Wide-field retinal mosaic image: 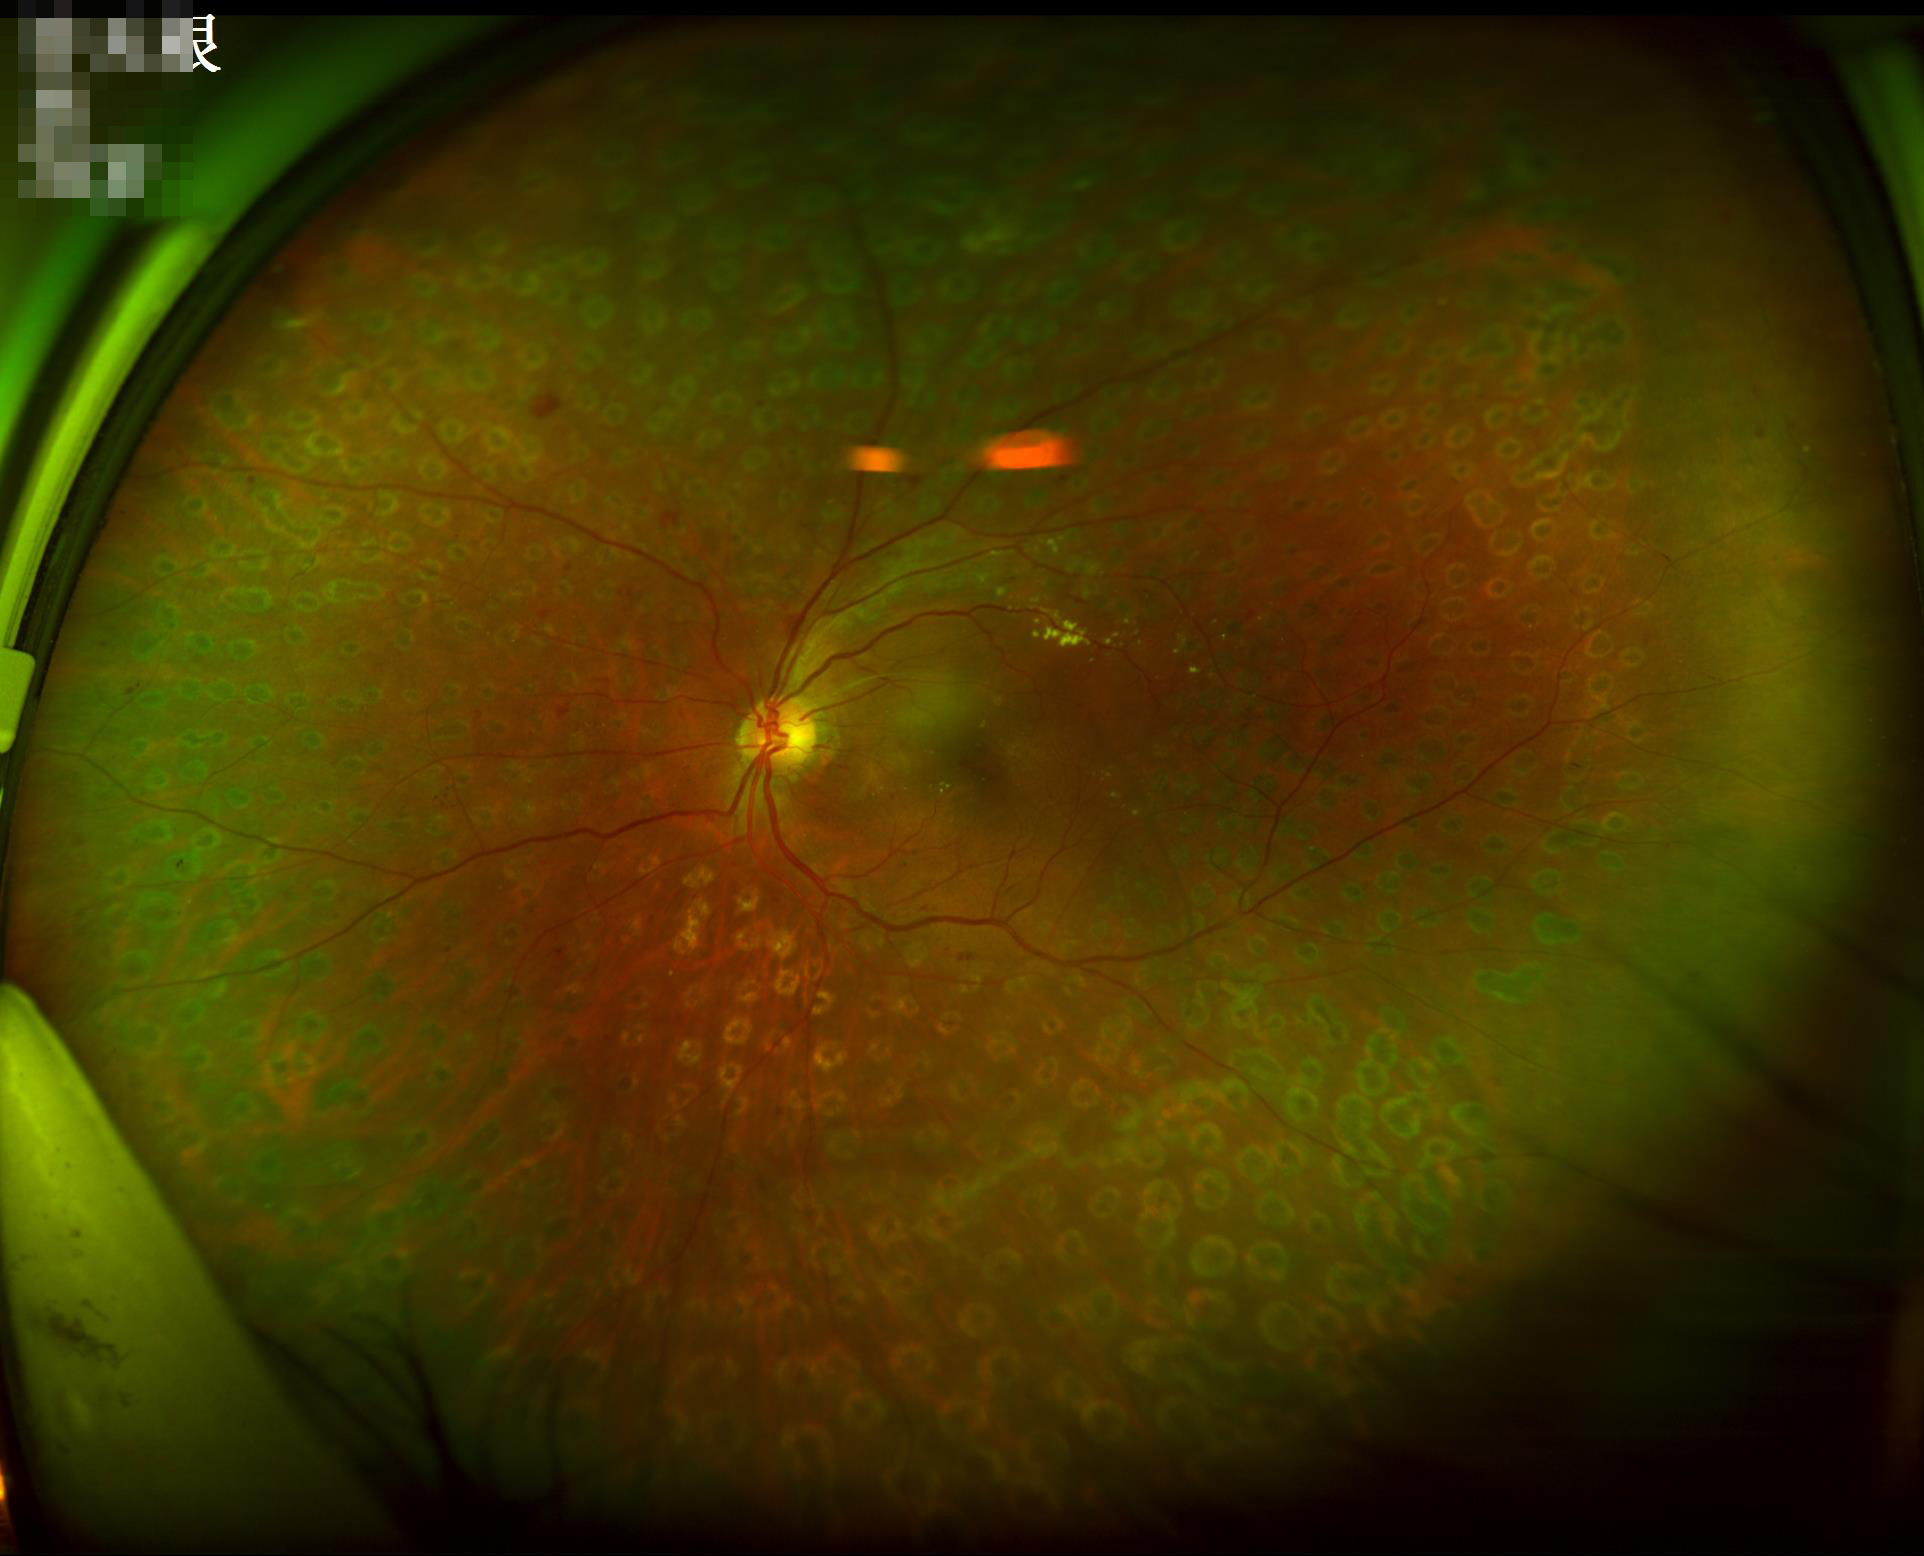

Image is sharp throughout the field.
Illumination is even.
Contrast is good.